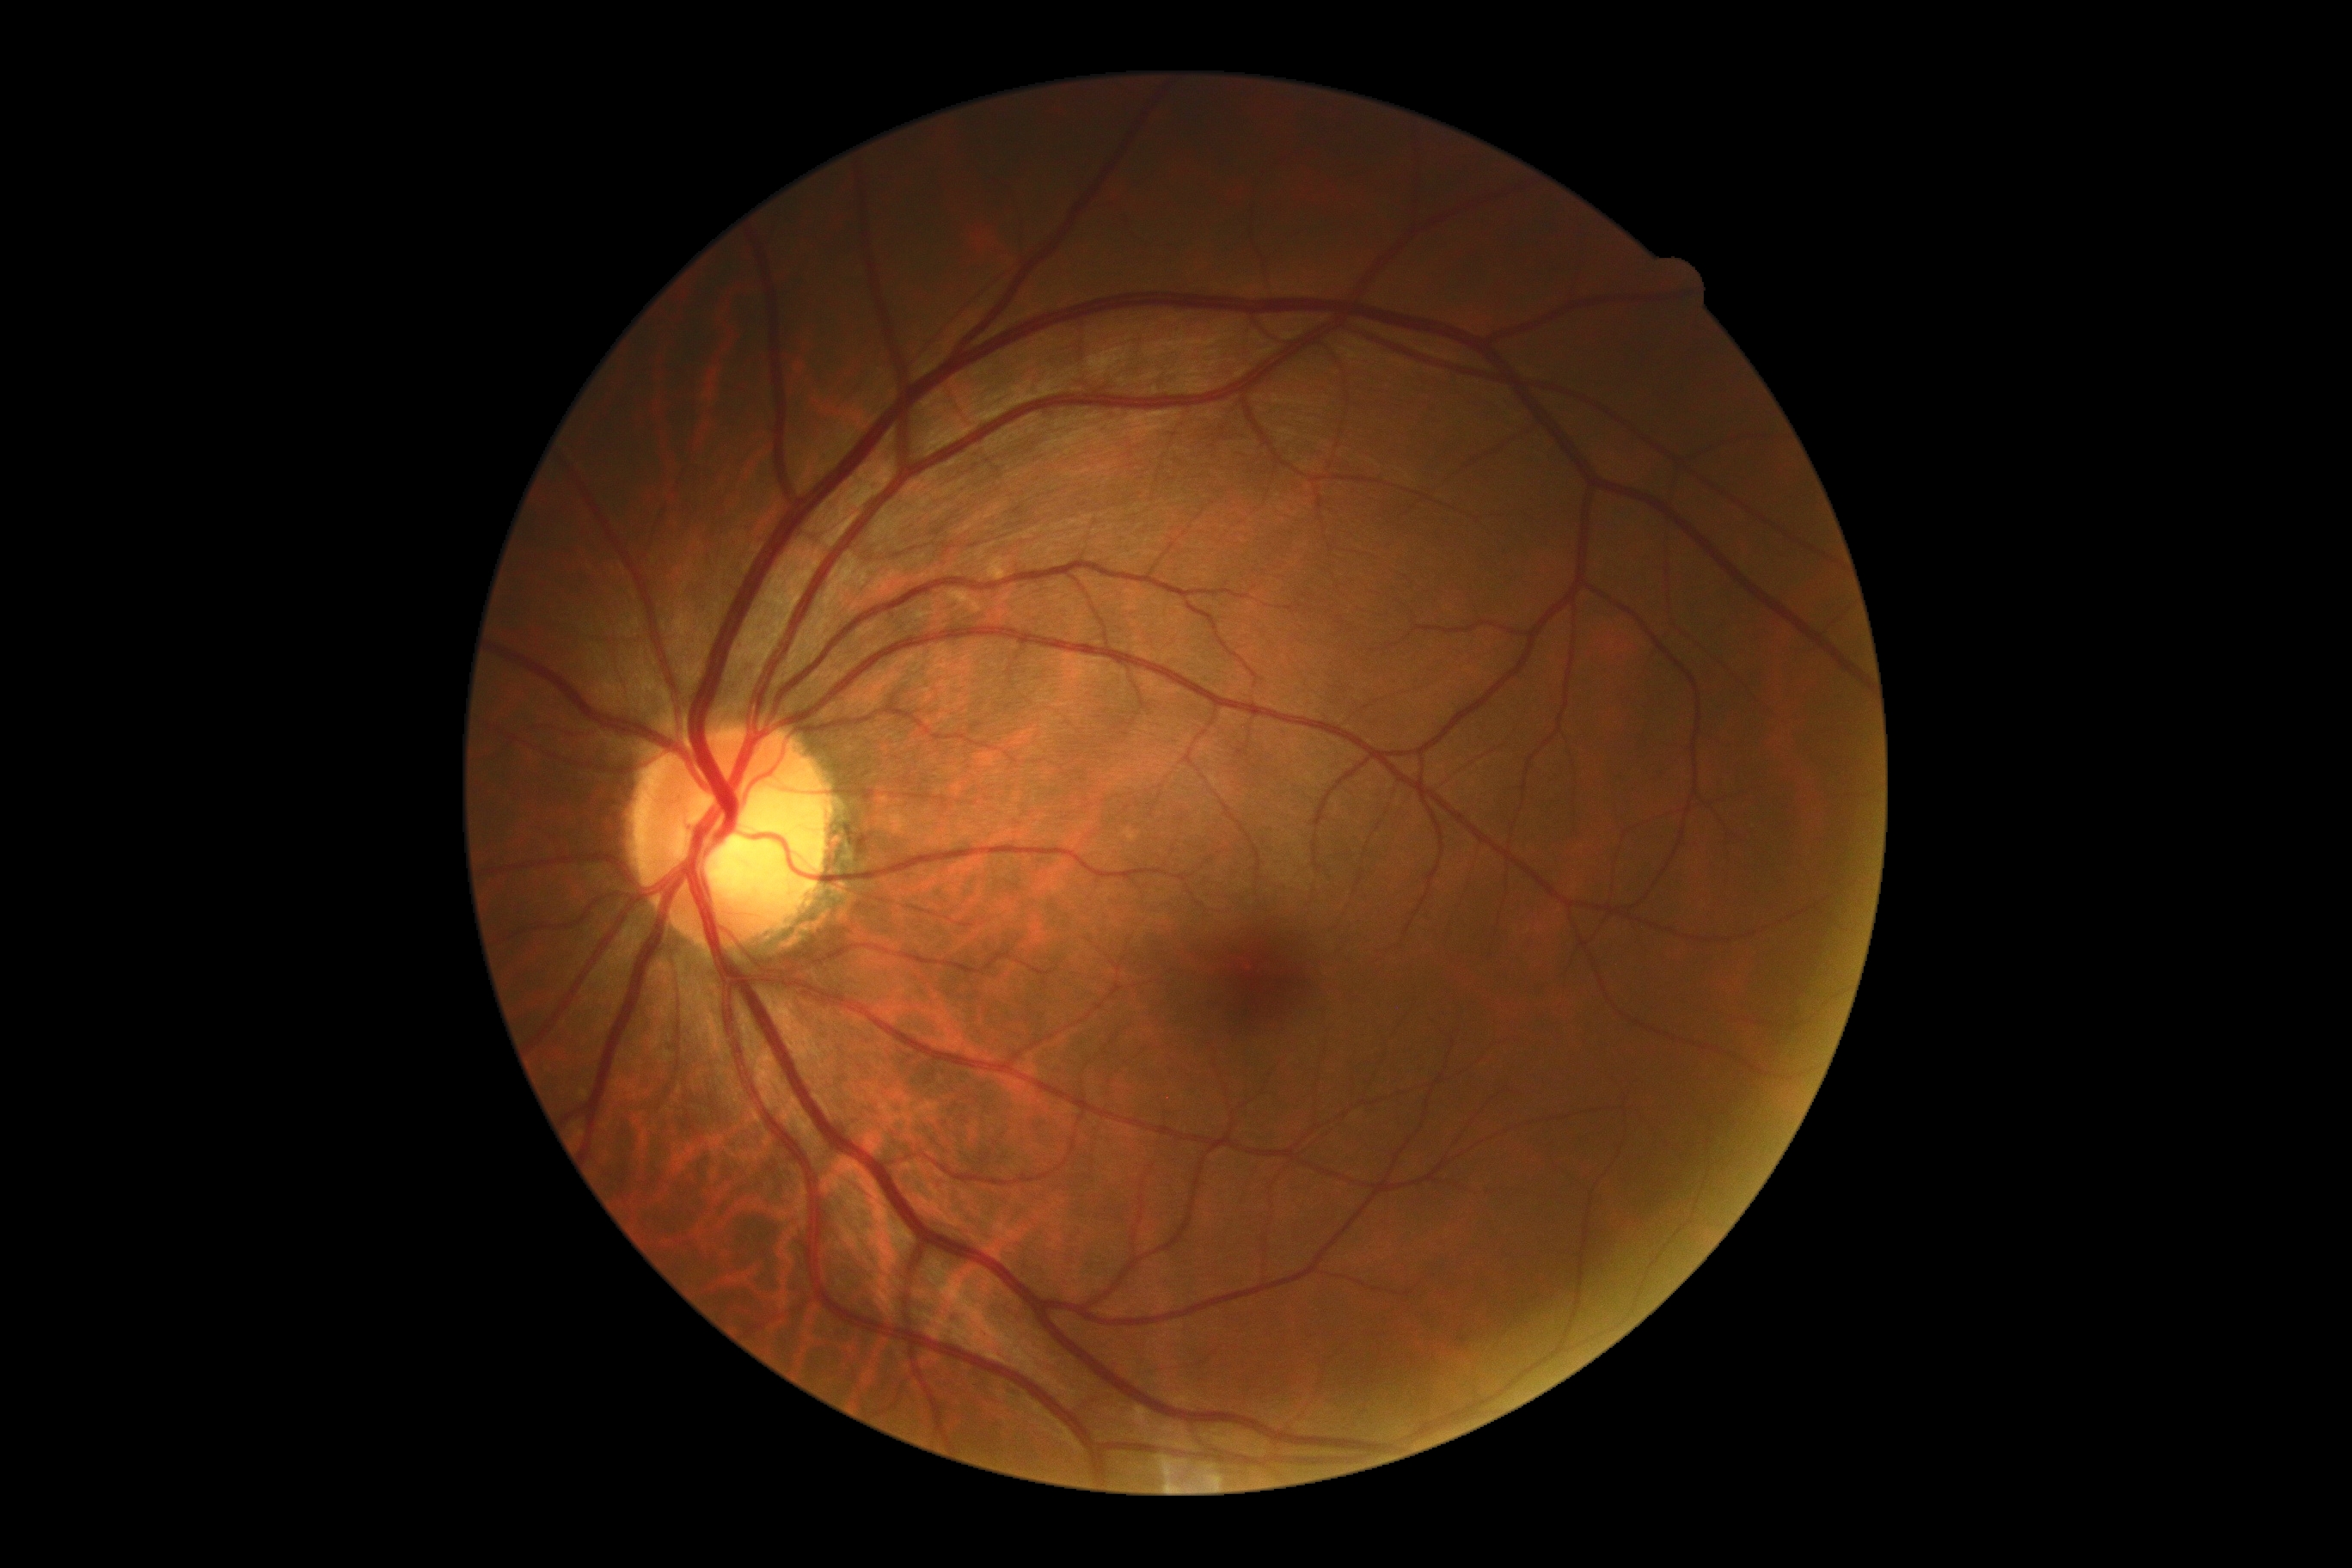

DR is 0.